1932 by 1923 pixels.
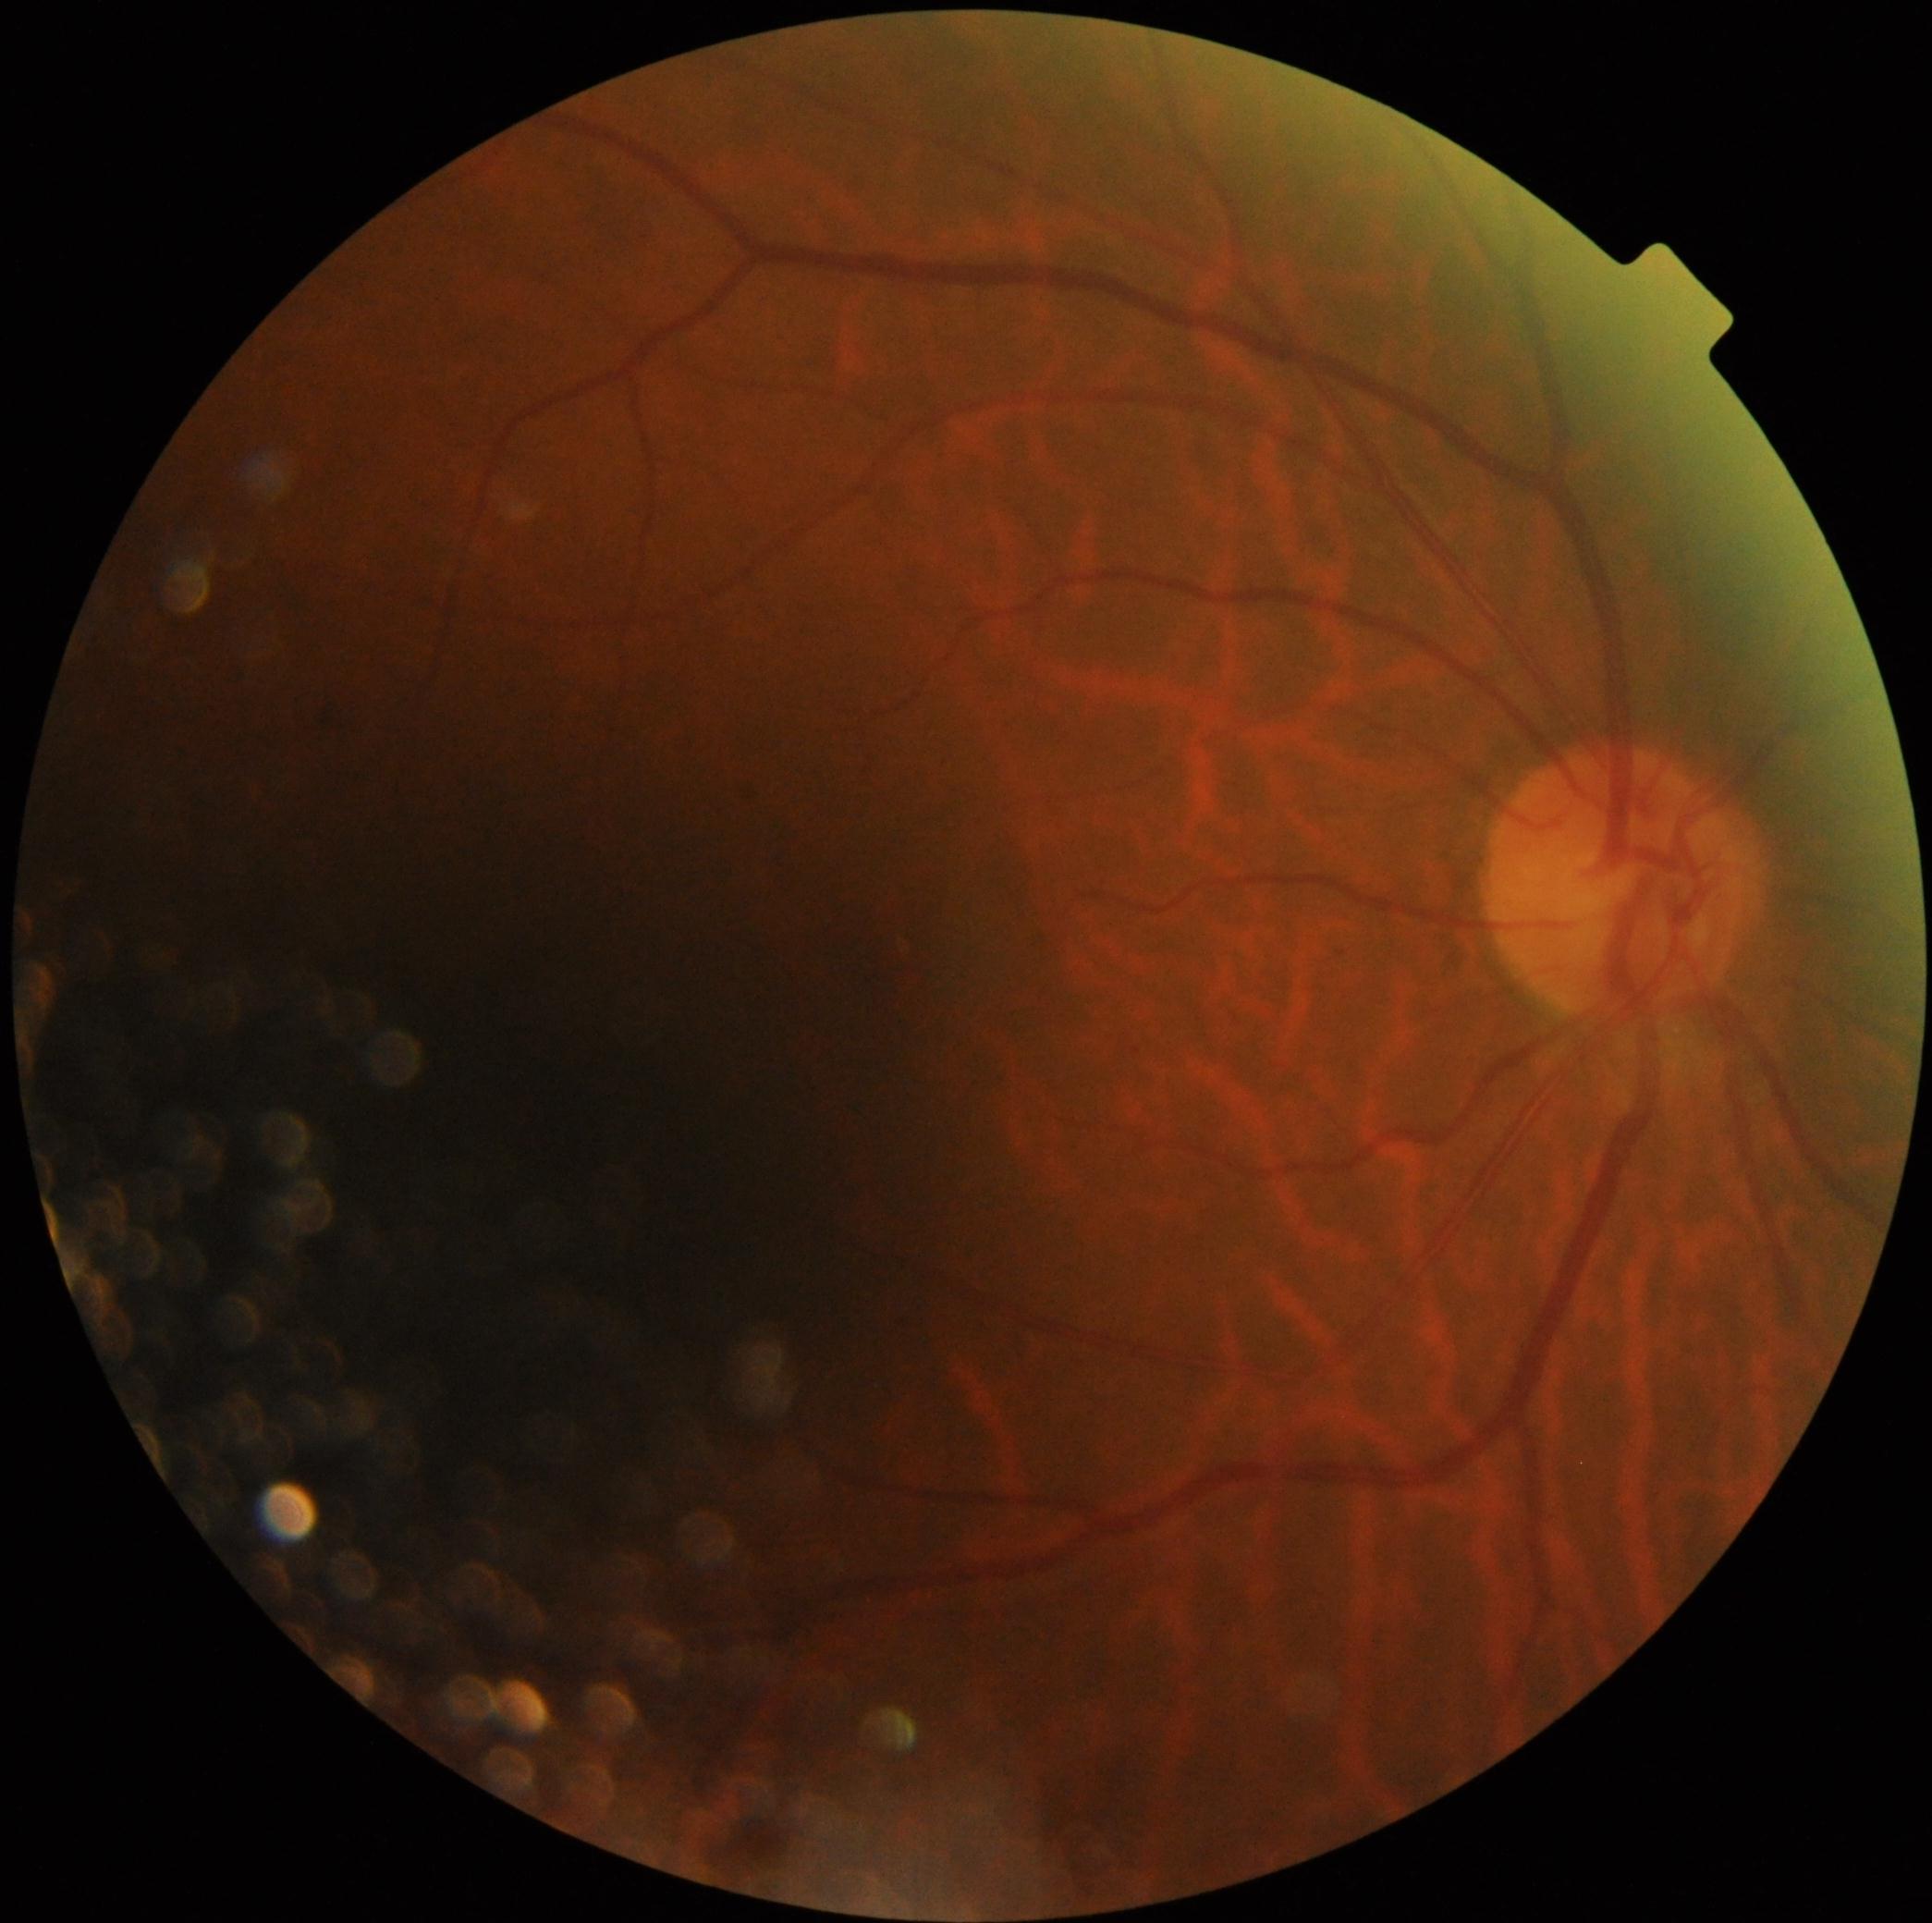 dr_impression: no signs of DR
dr_grade: grade 0 (no apparent retinopathy)